Image size 2352x1568 — 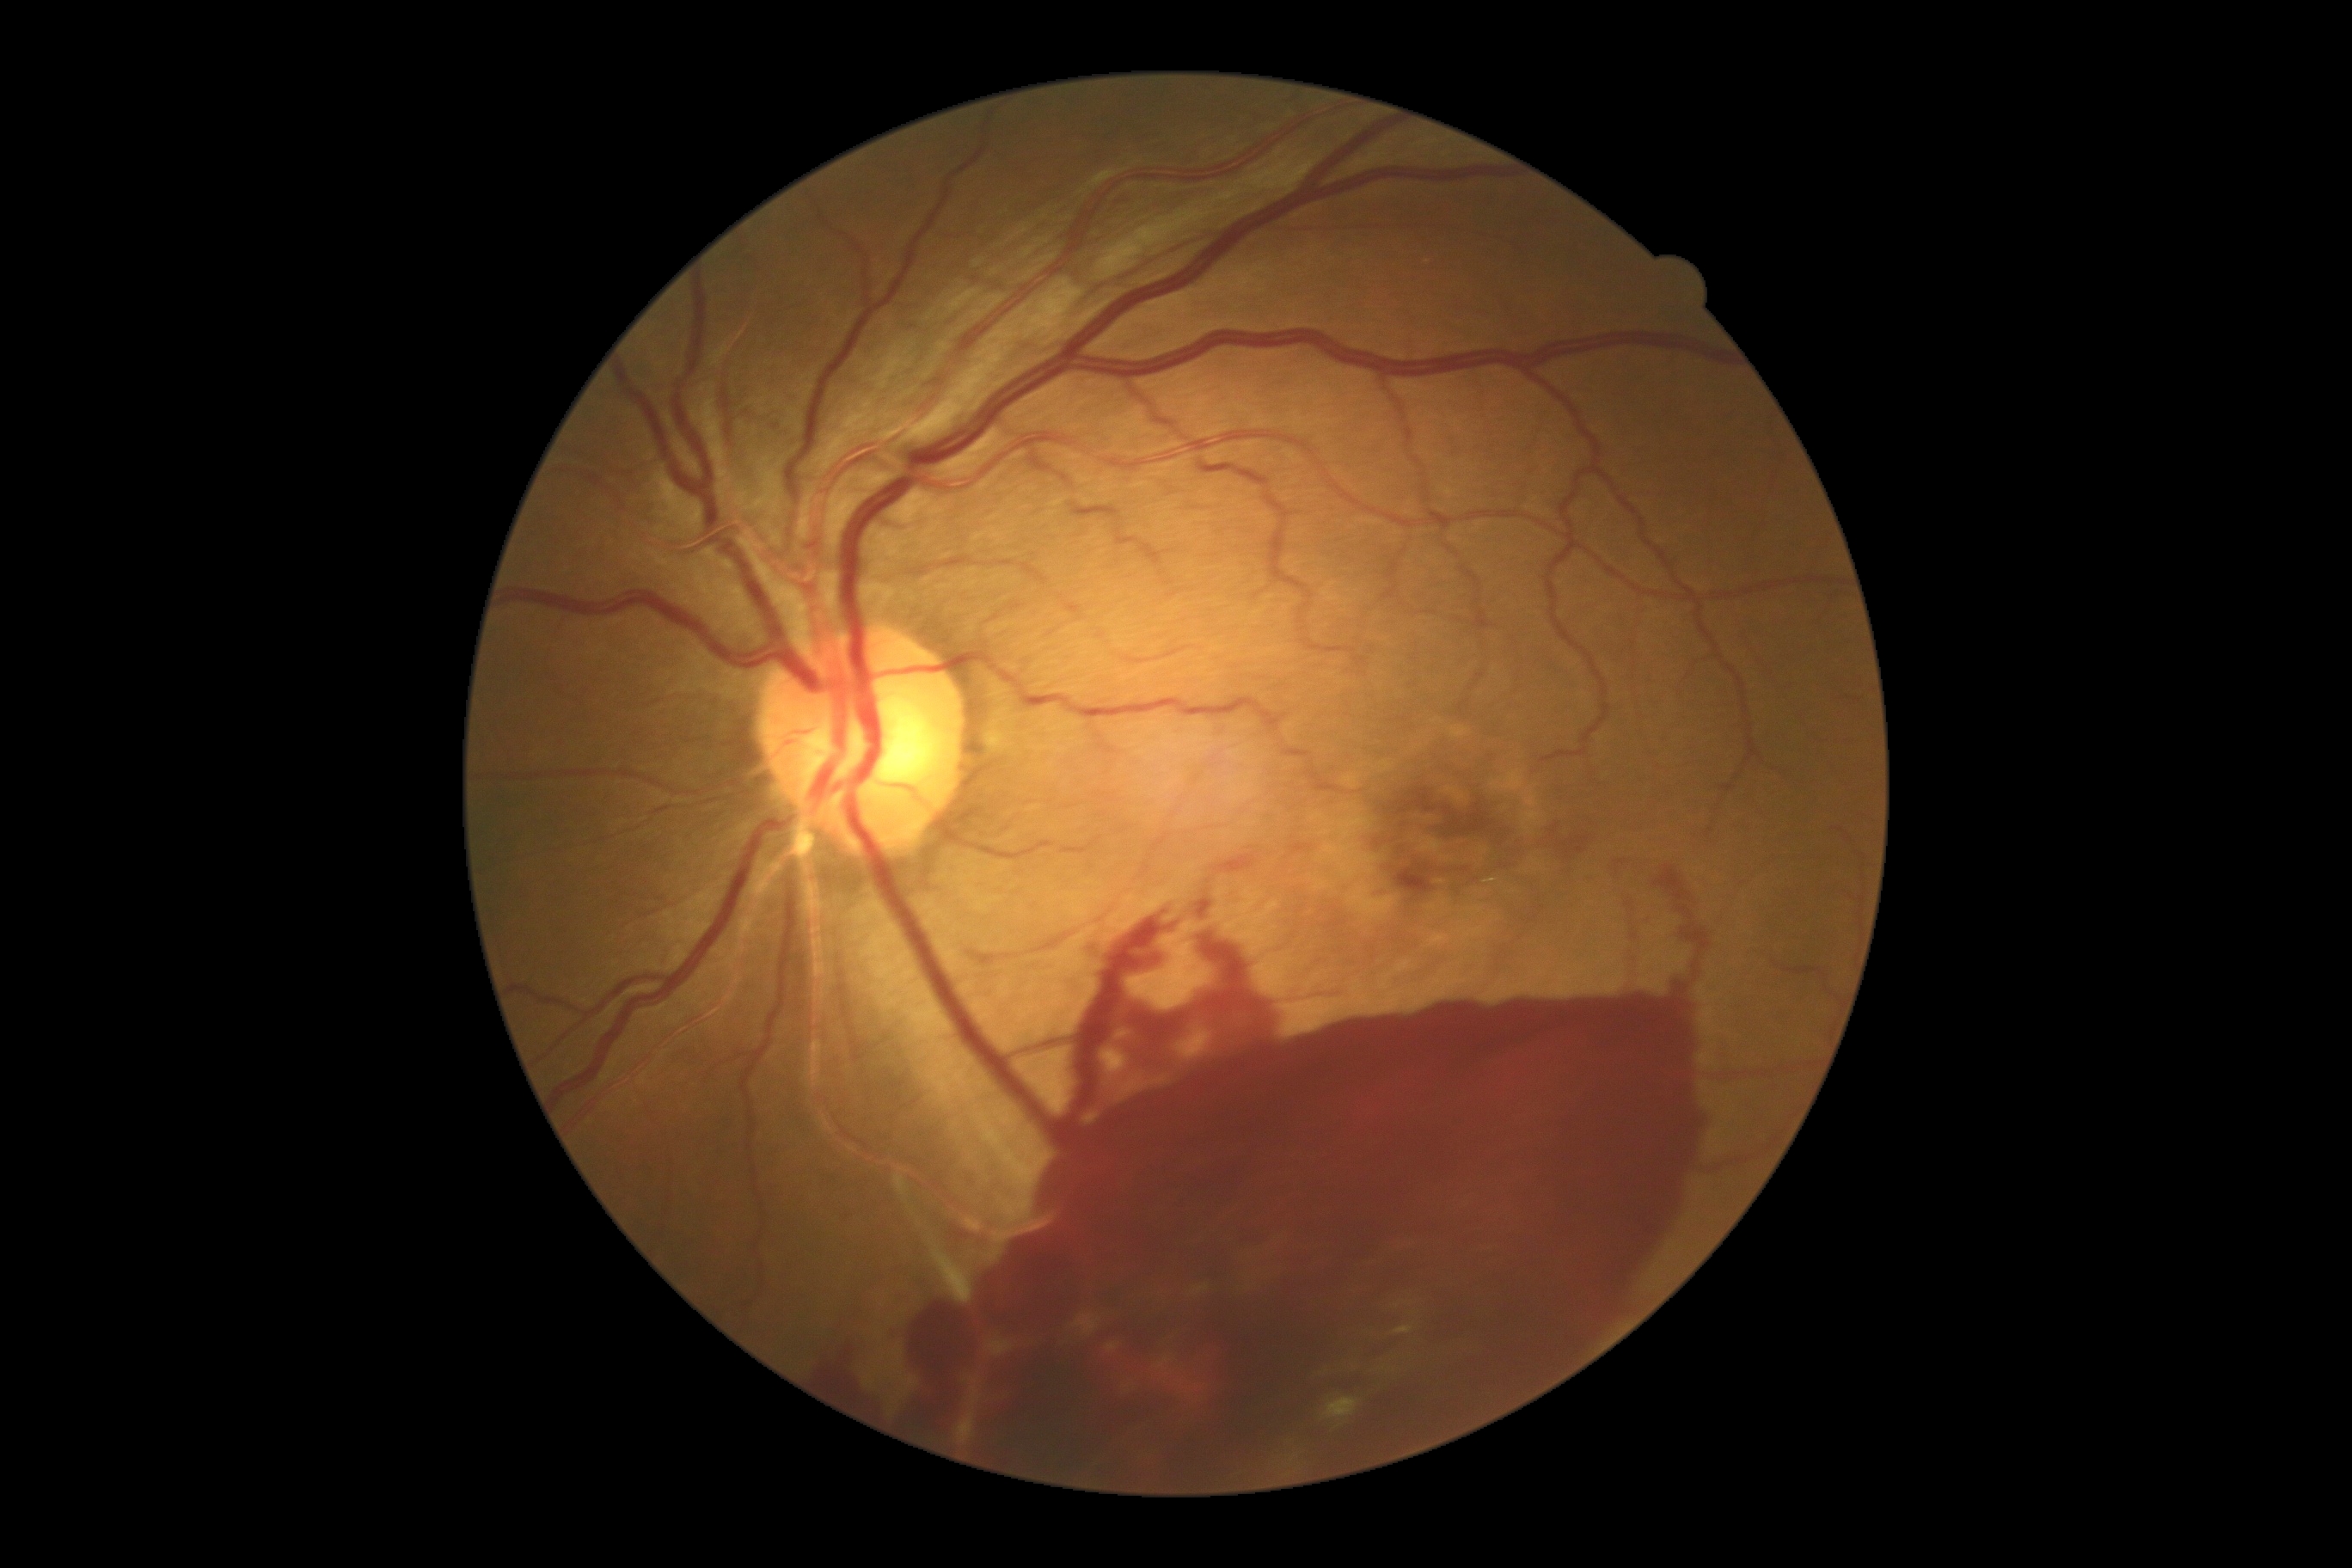
DR grade: 4 (PDR).